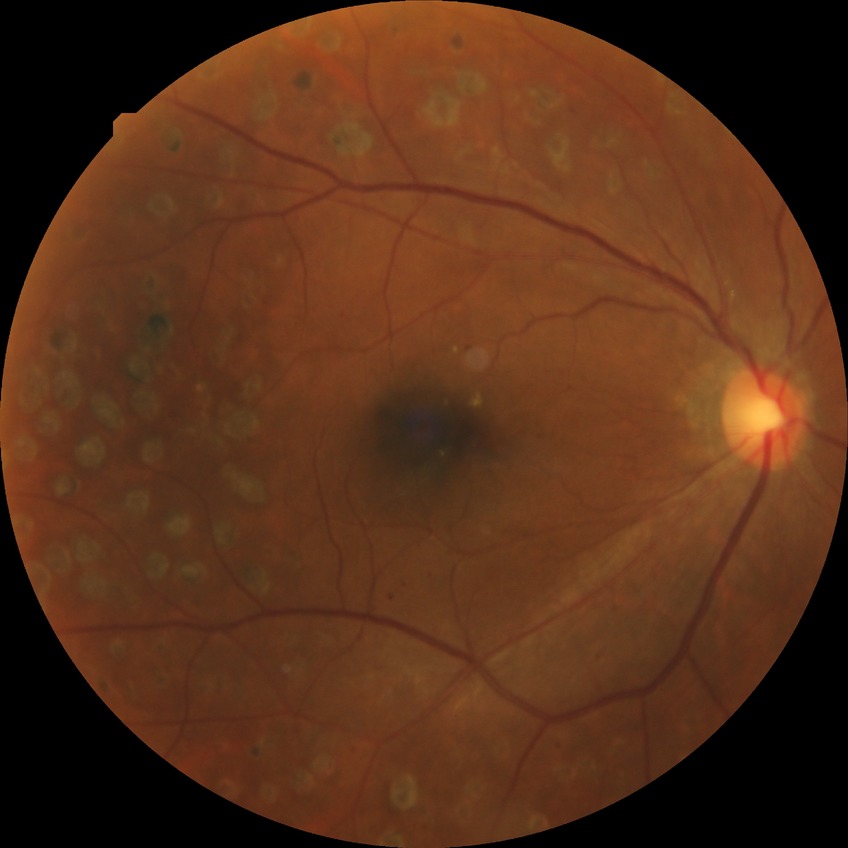

Diabetic retinopathy stage is proliferative diabetic retinopathy.